Retinal fundus photograph · 45° FOV · image size 2352x1568 — 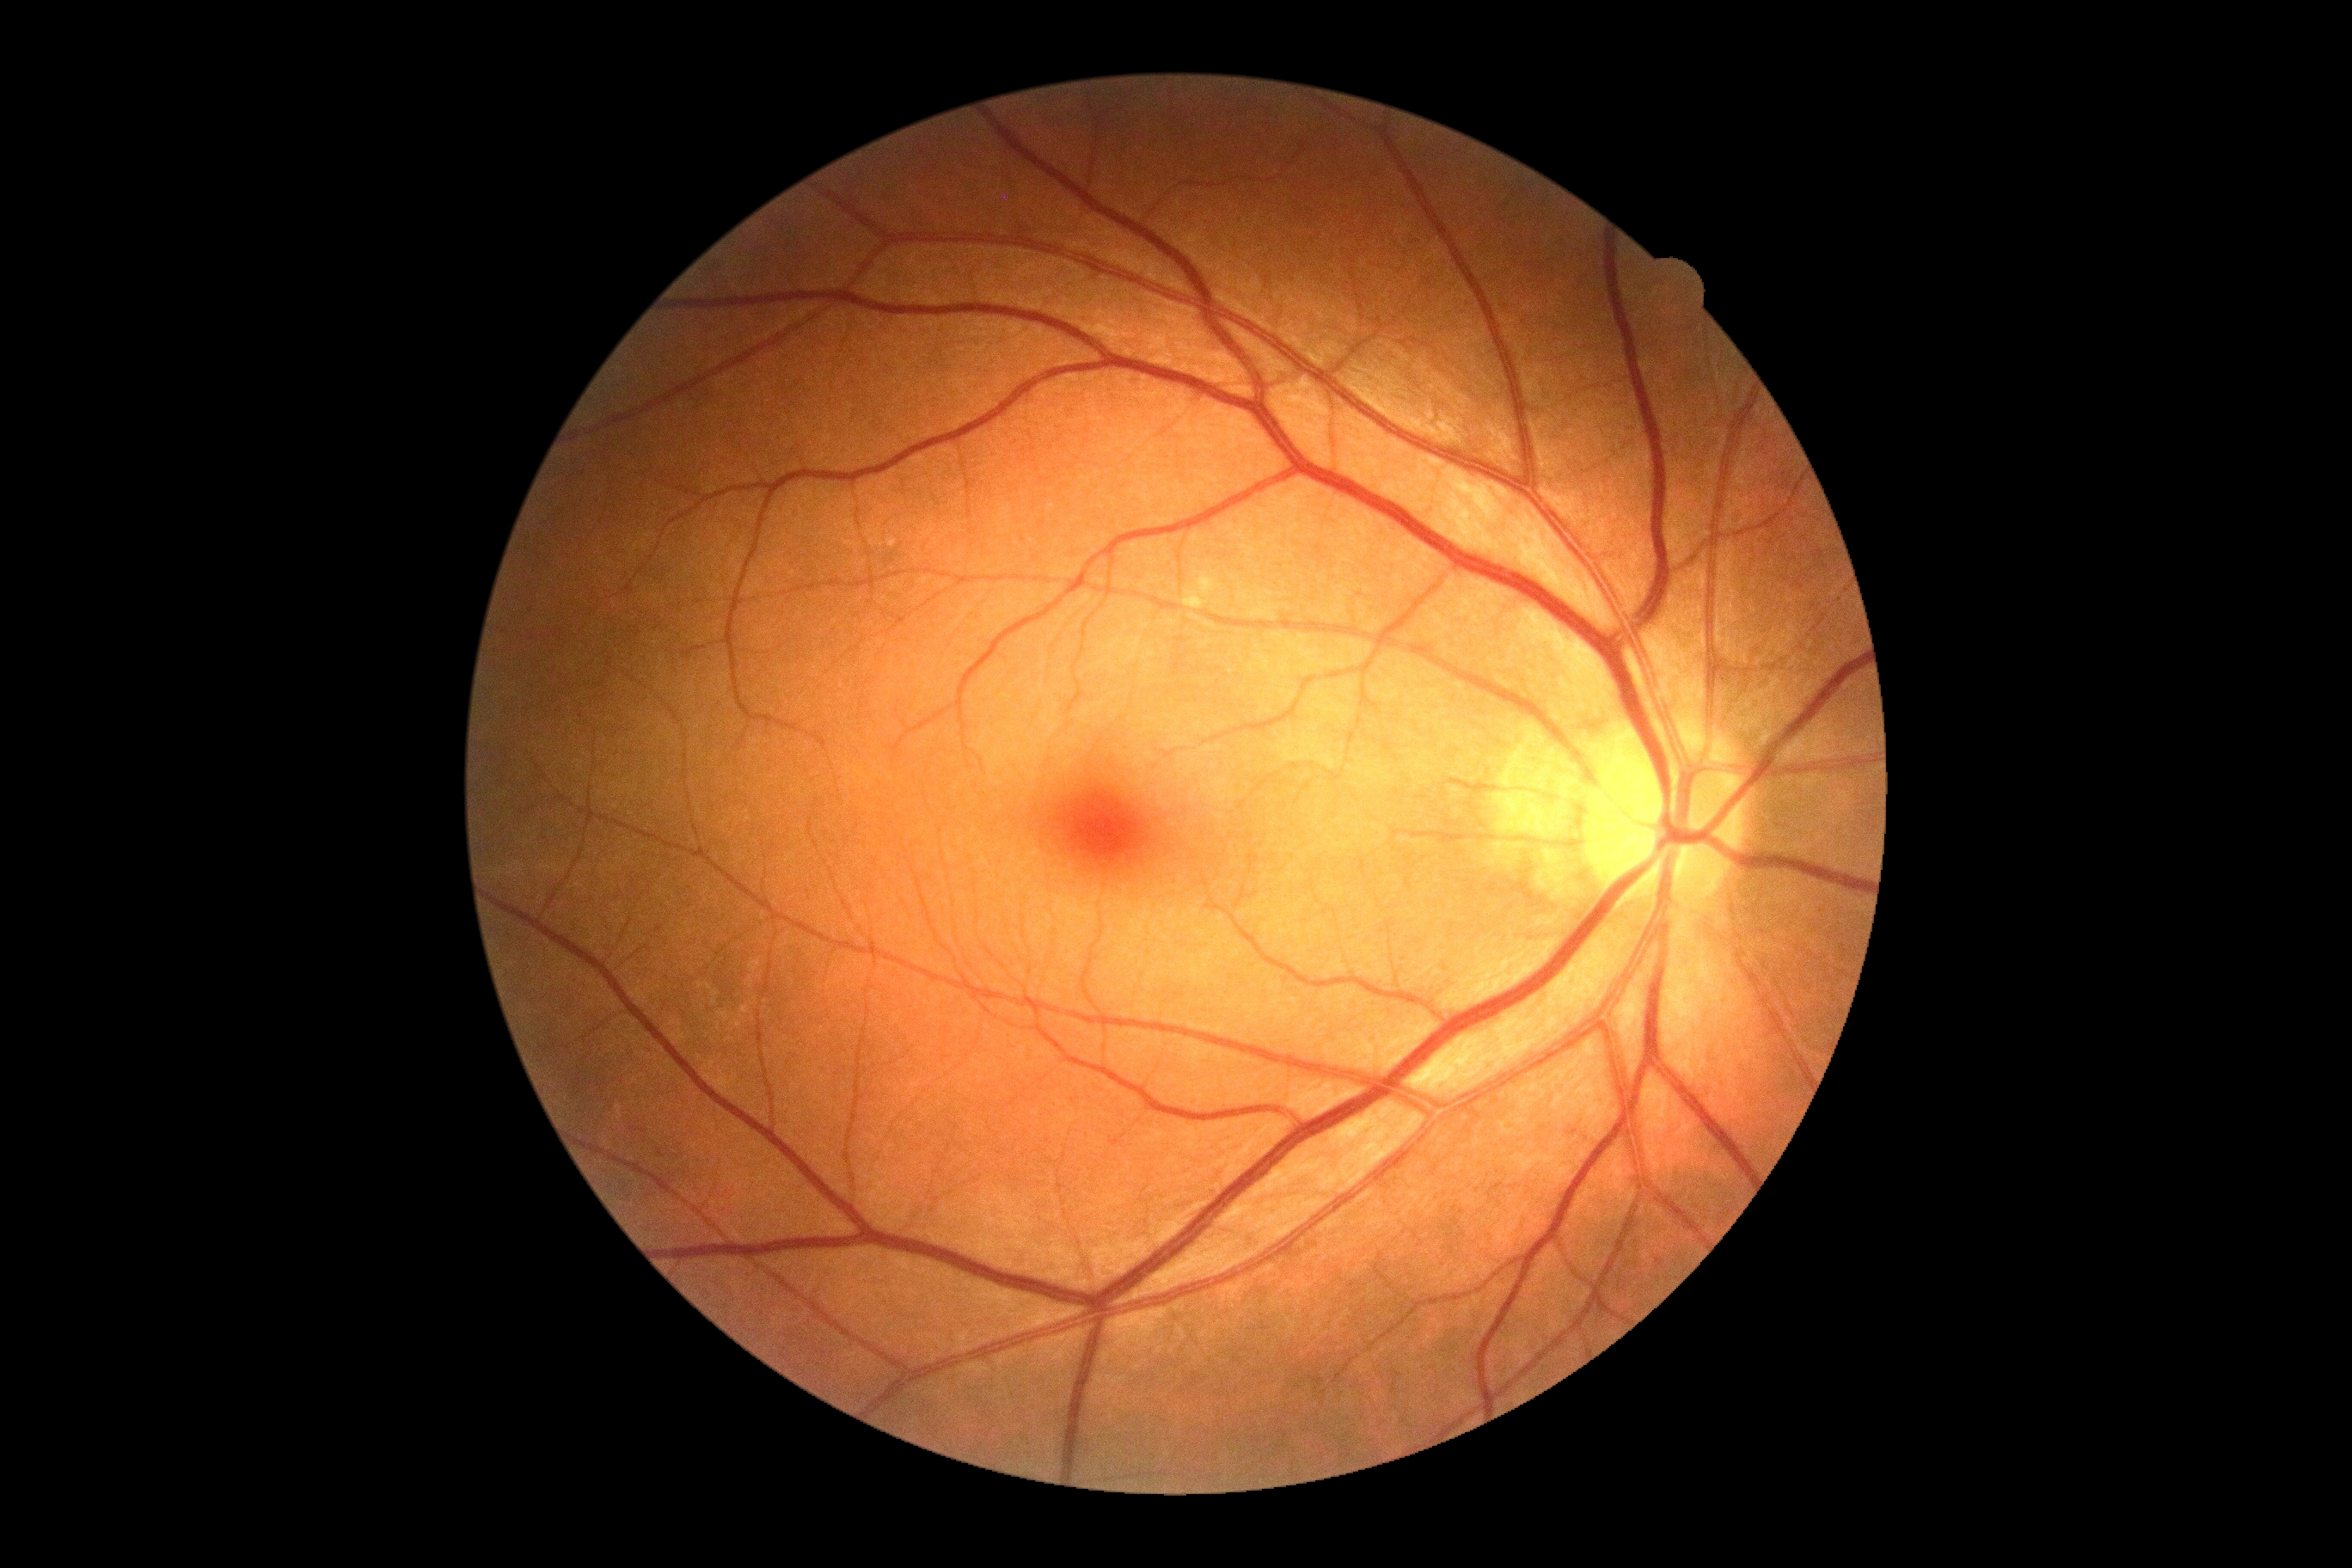 Retinopathy grade is 0.